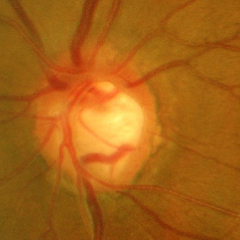
Q: Does this eye have glaucoma?
A: Yes — advanced glaucomatous optic neuropathy. (Criteria: near-total cupping of the optic nerve head, with or without severe visual field loss within the central 10 degrees of fixation.)